Modified Davis grading · 45 degree fundus photograph
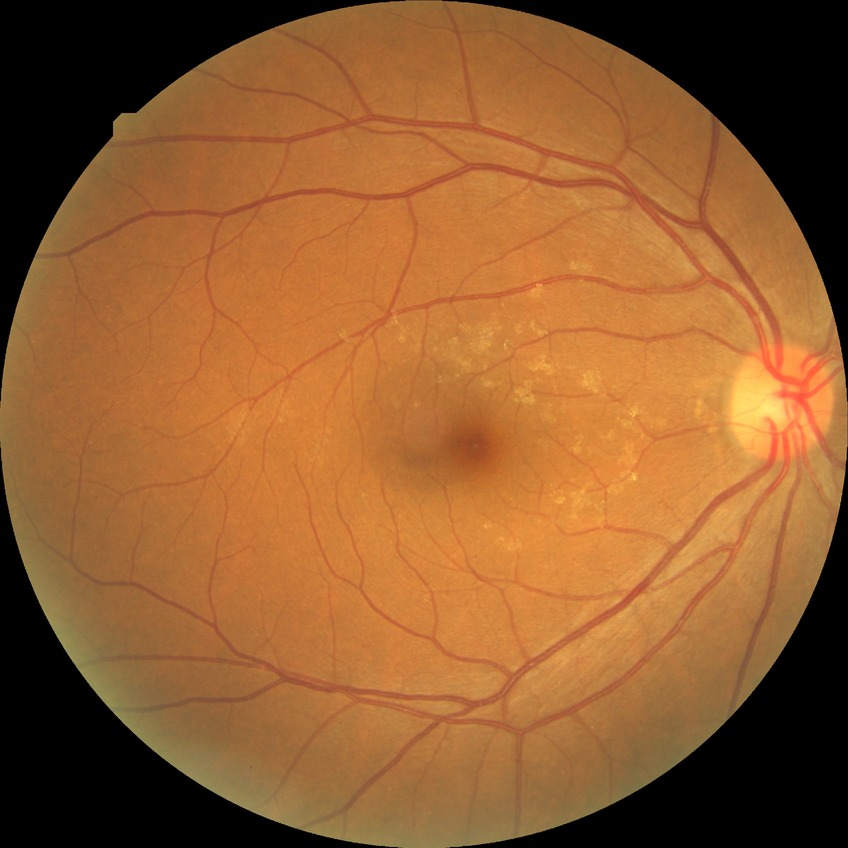

Diabetic retinopathy (DR): NDR (no diabetic retinopathy).